Retinal fundus photograph — 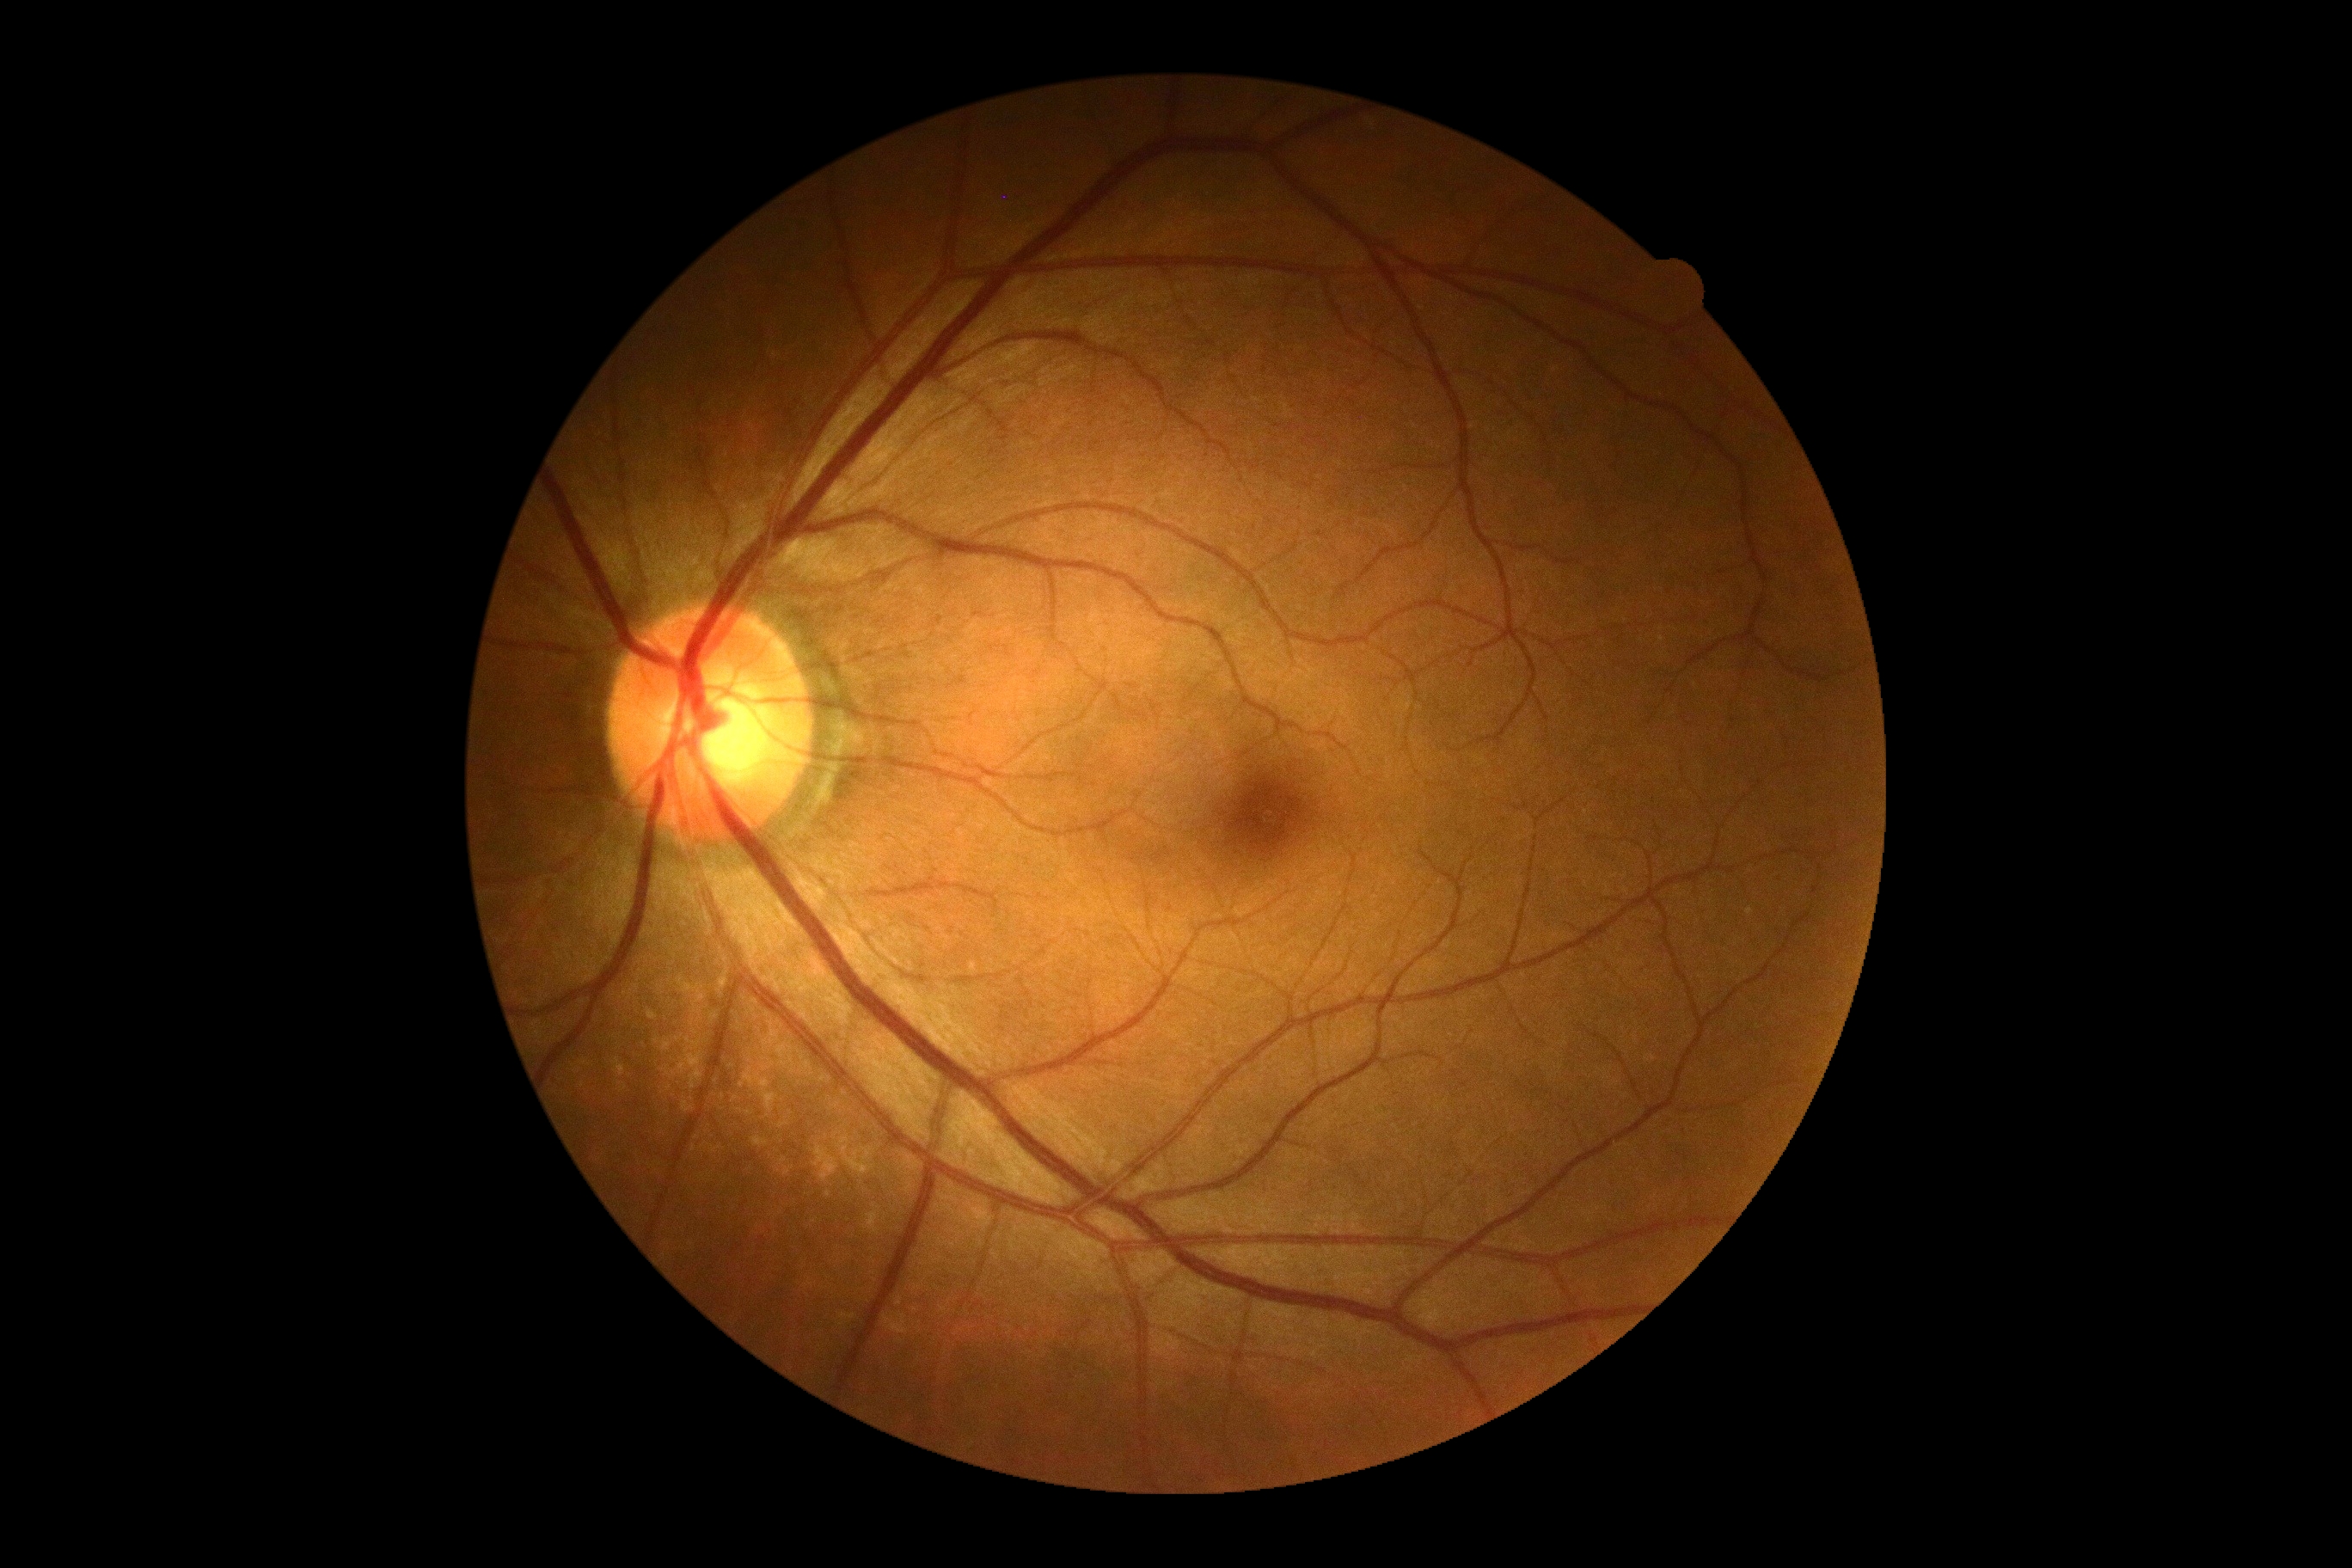
  dr_grade: 0/4